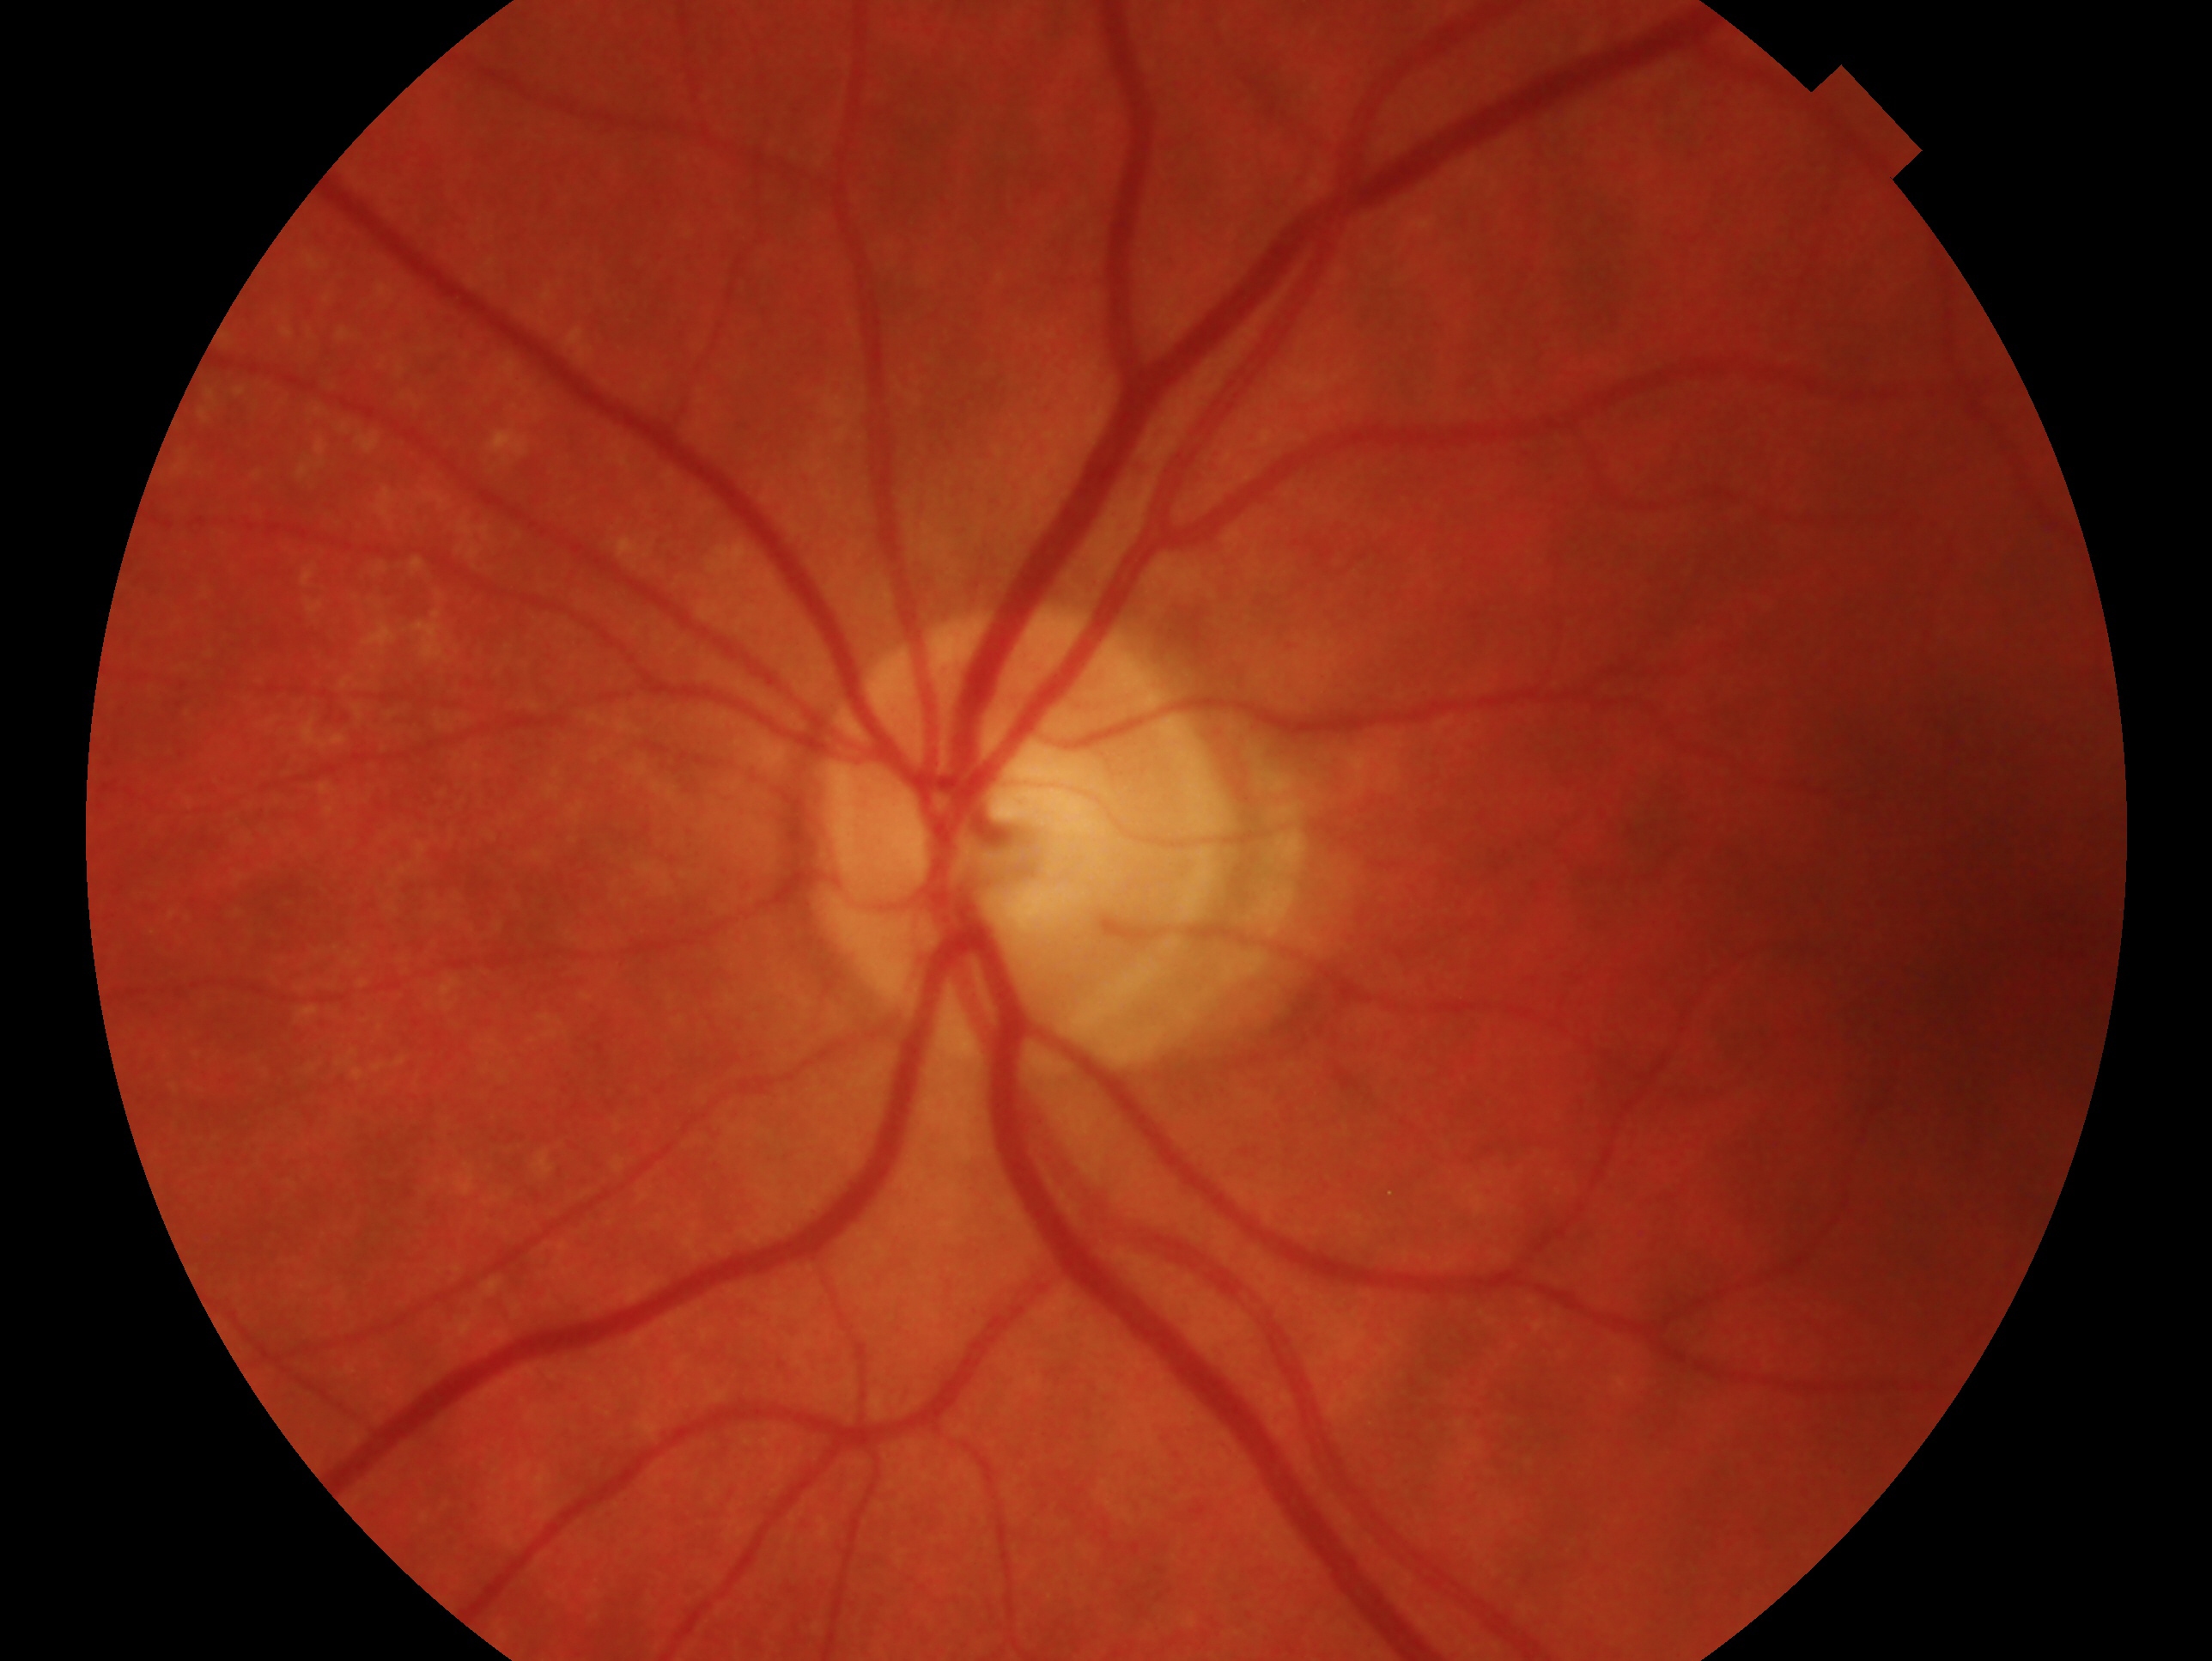 Assessment — no signs of glaucoma.
The image shows the OS.